DR severity per modified Davis staging: 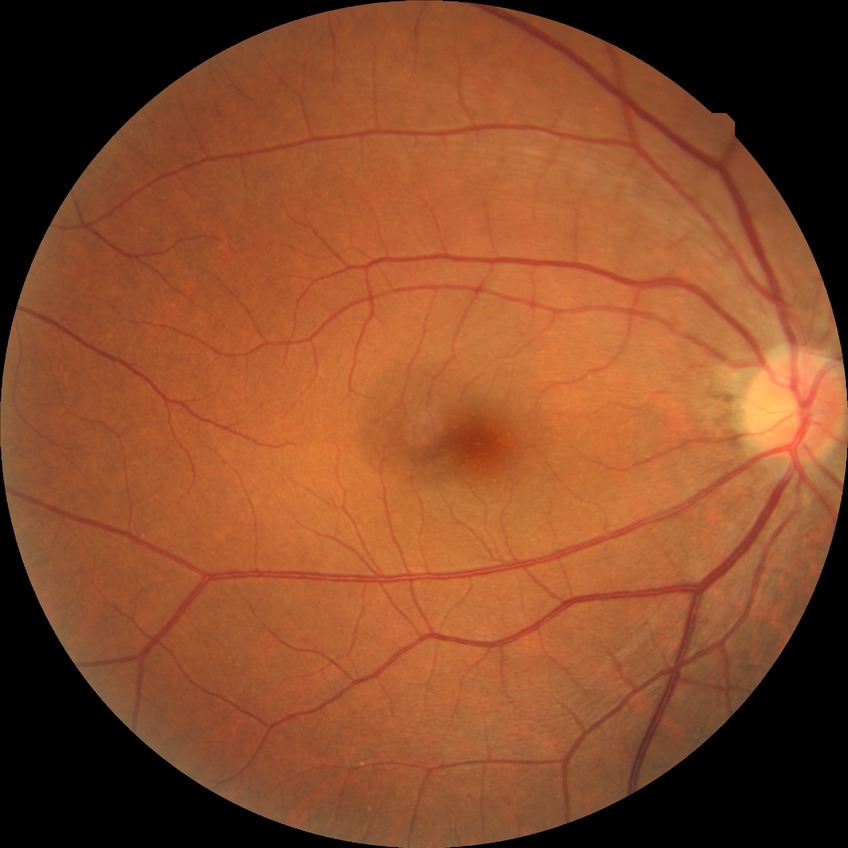
No diabetic retinal disease findings. Davis grade is NDR.